Graded on the modified Davis scale. CFP.
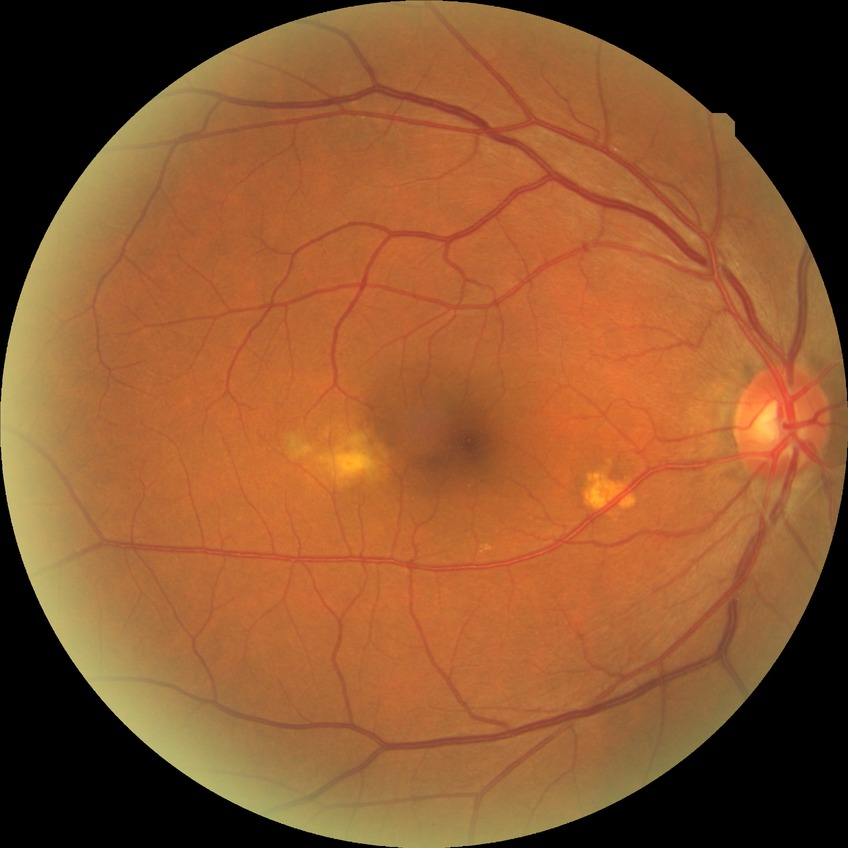
davis_grade: no diabetic retinopathy